CFP; 2352x1568:
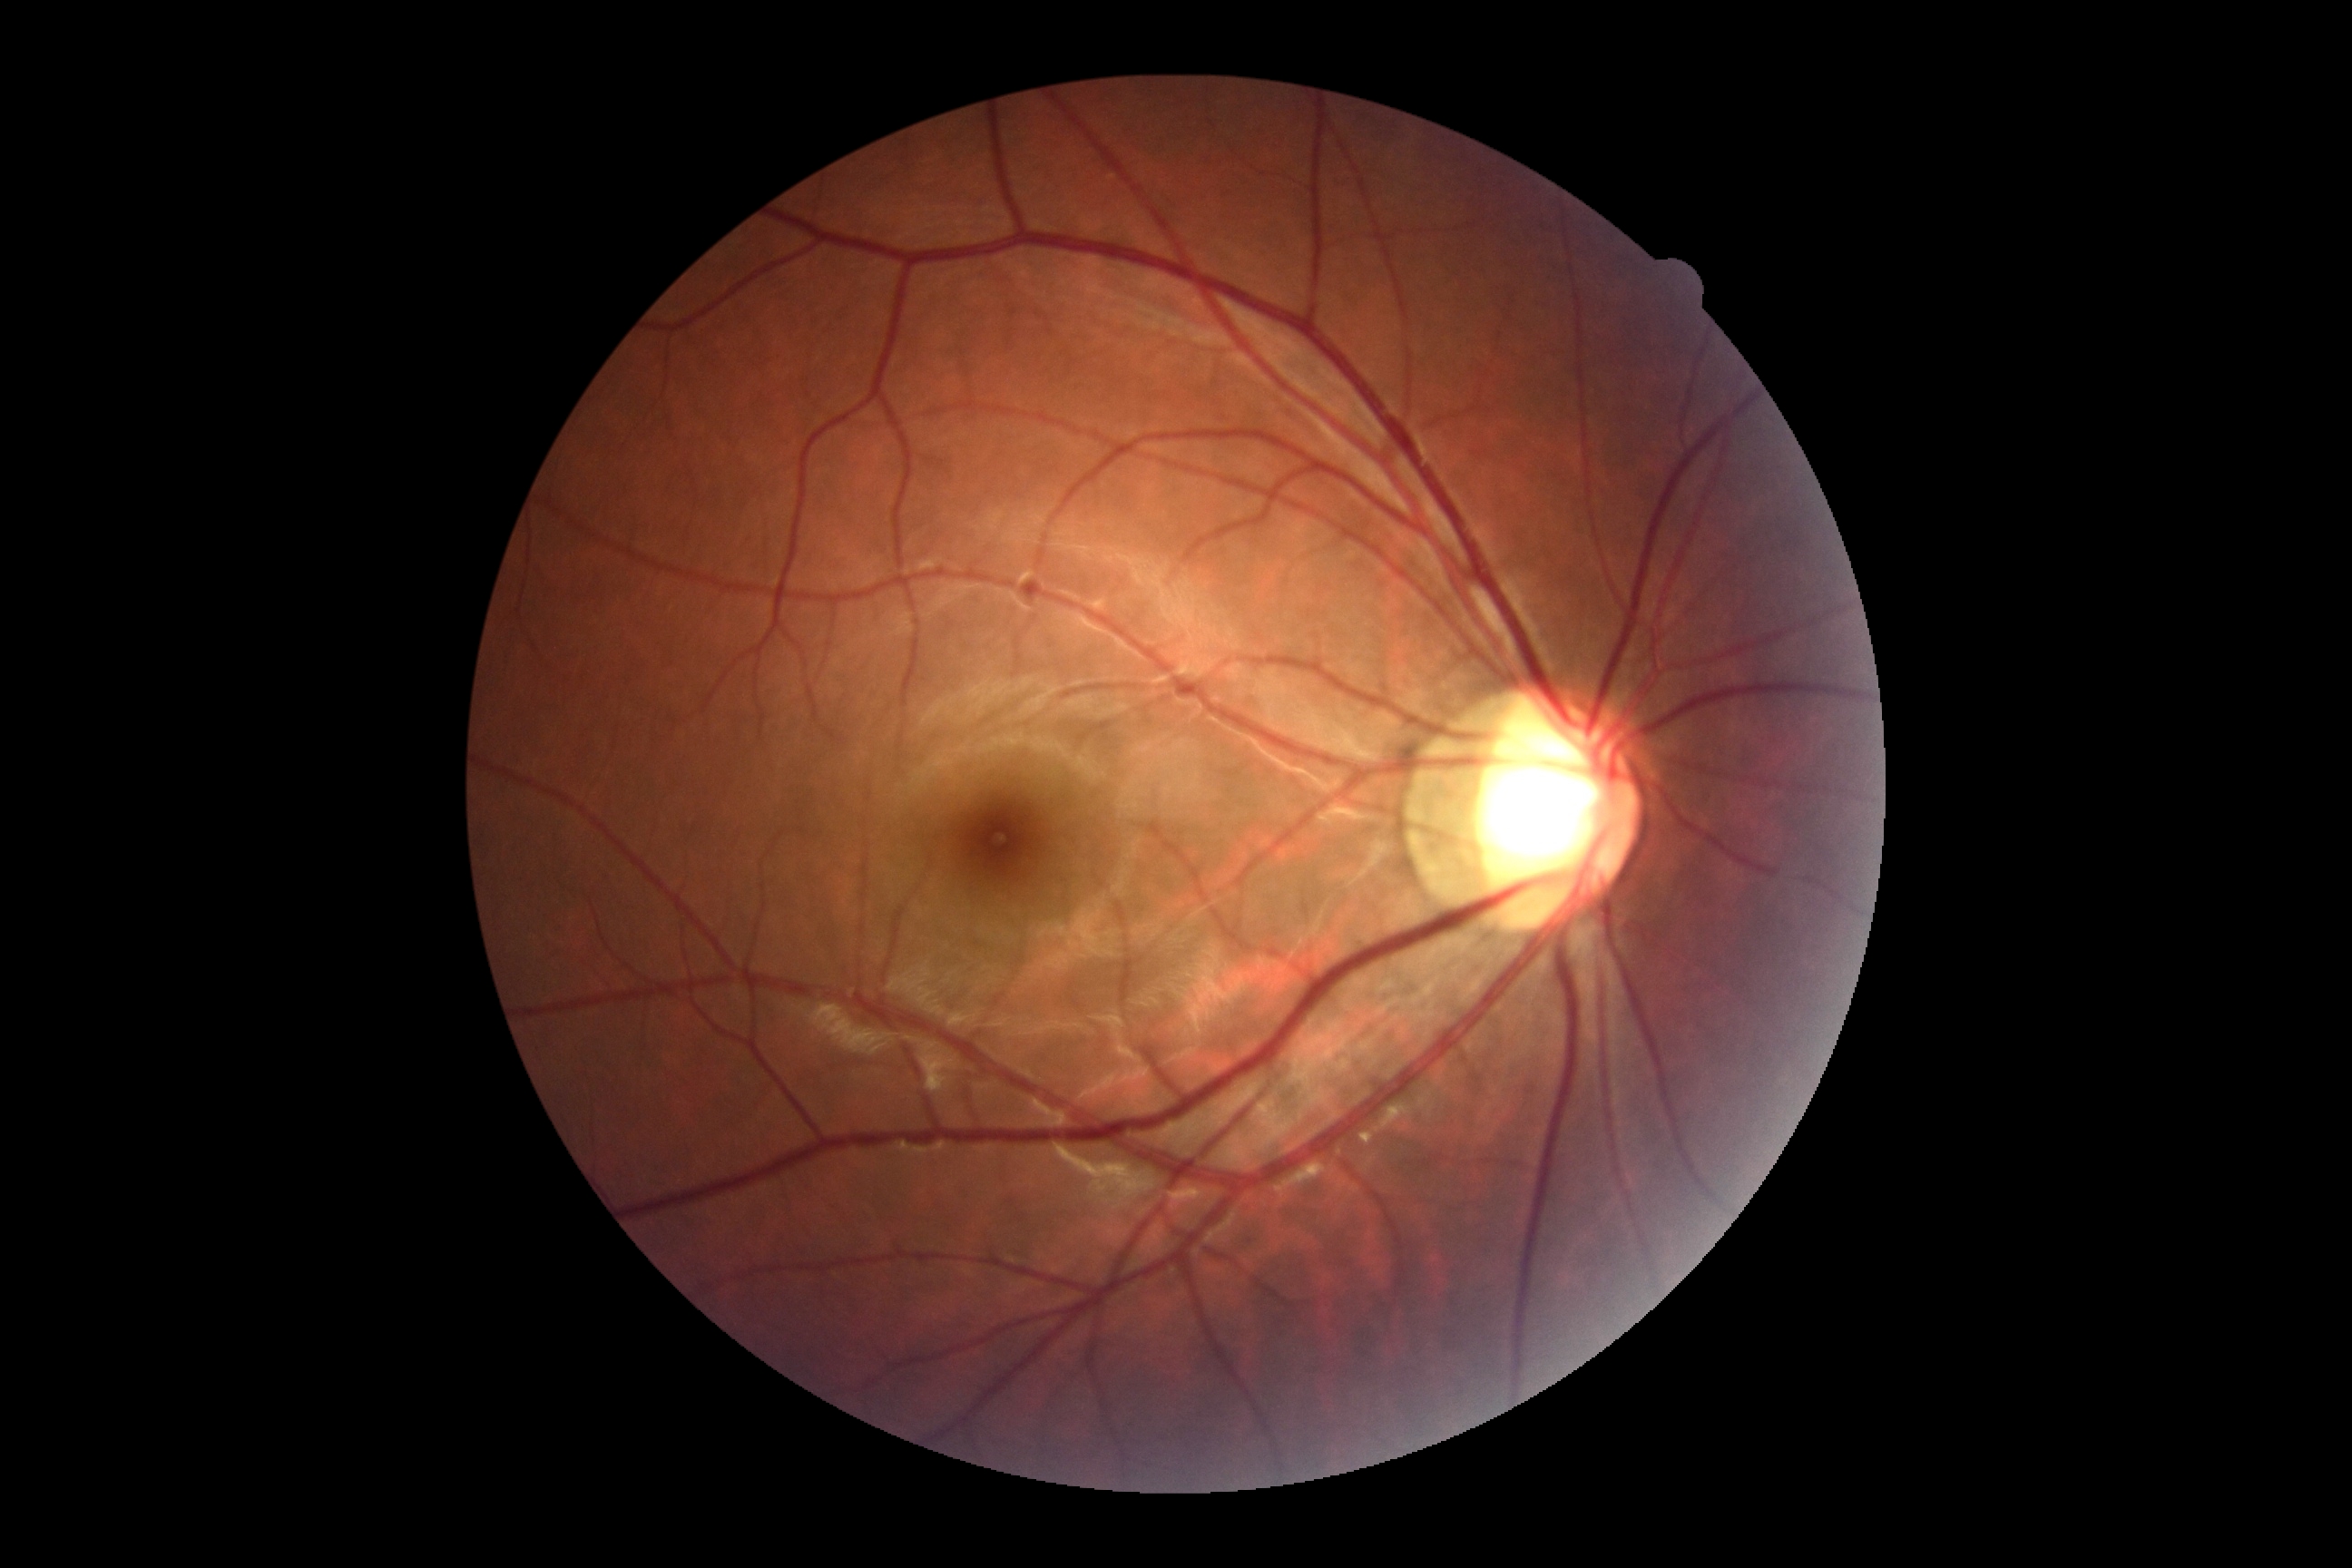
Diabetic retinopathy grade is 0.